RetCam wide-field infant fundus image: 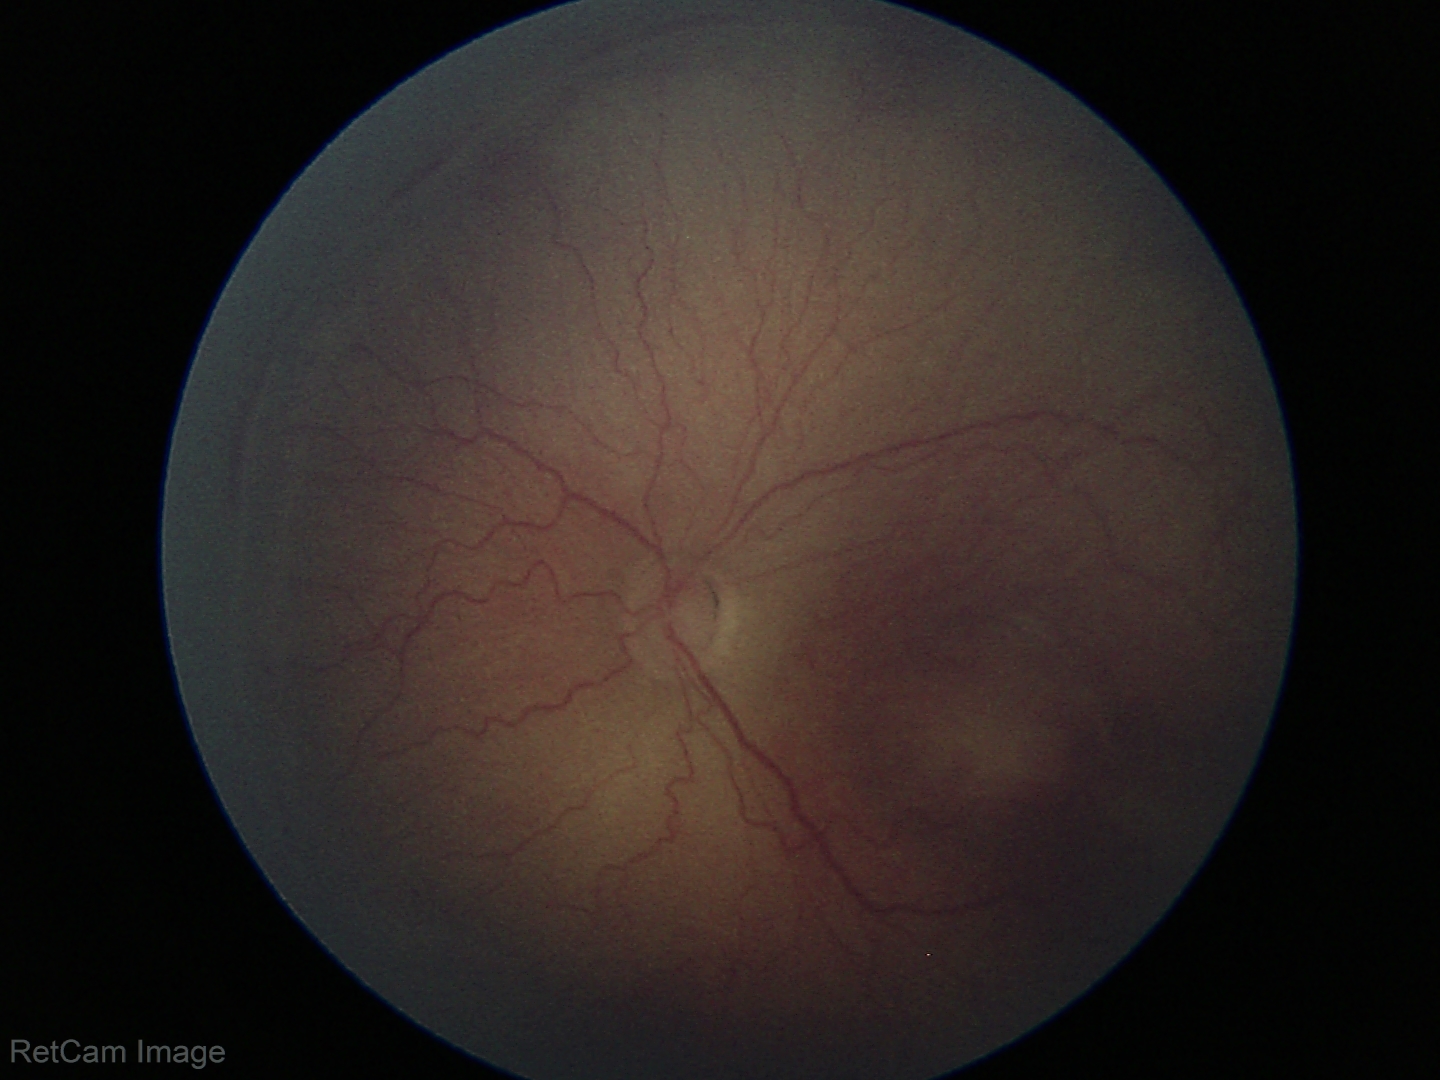
Screening series with retinopathy of prematurity (ROP) stage 2. Plus disease absent.